Graded on the modified Davis scale: 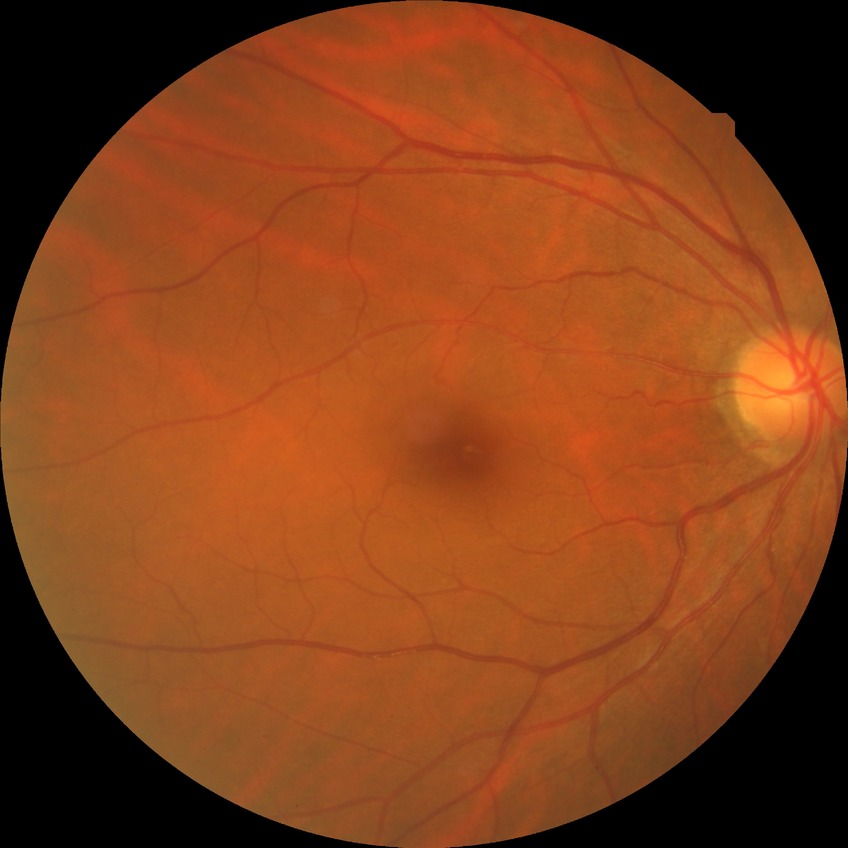
– DR — NDR
– DR impression — no apparent DR